1240x1240px · wide-field fundus photograph of an infant:
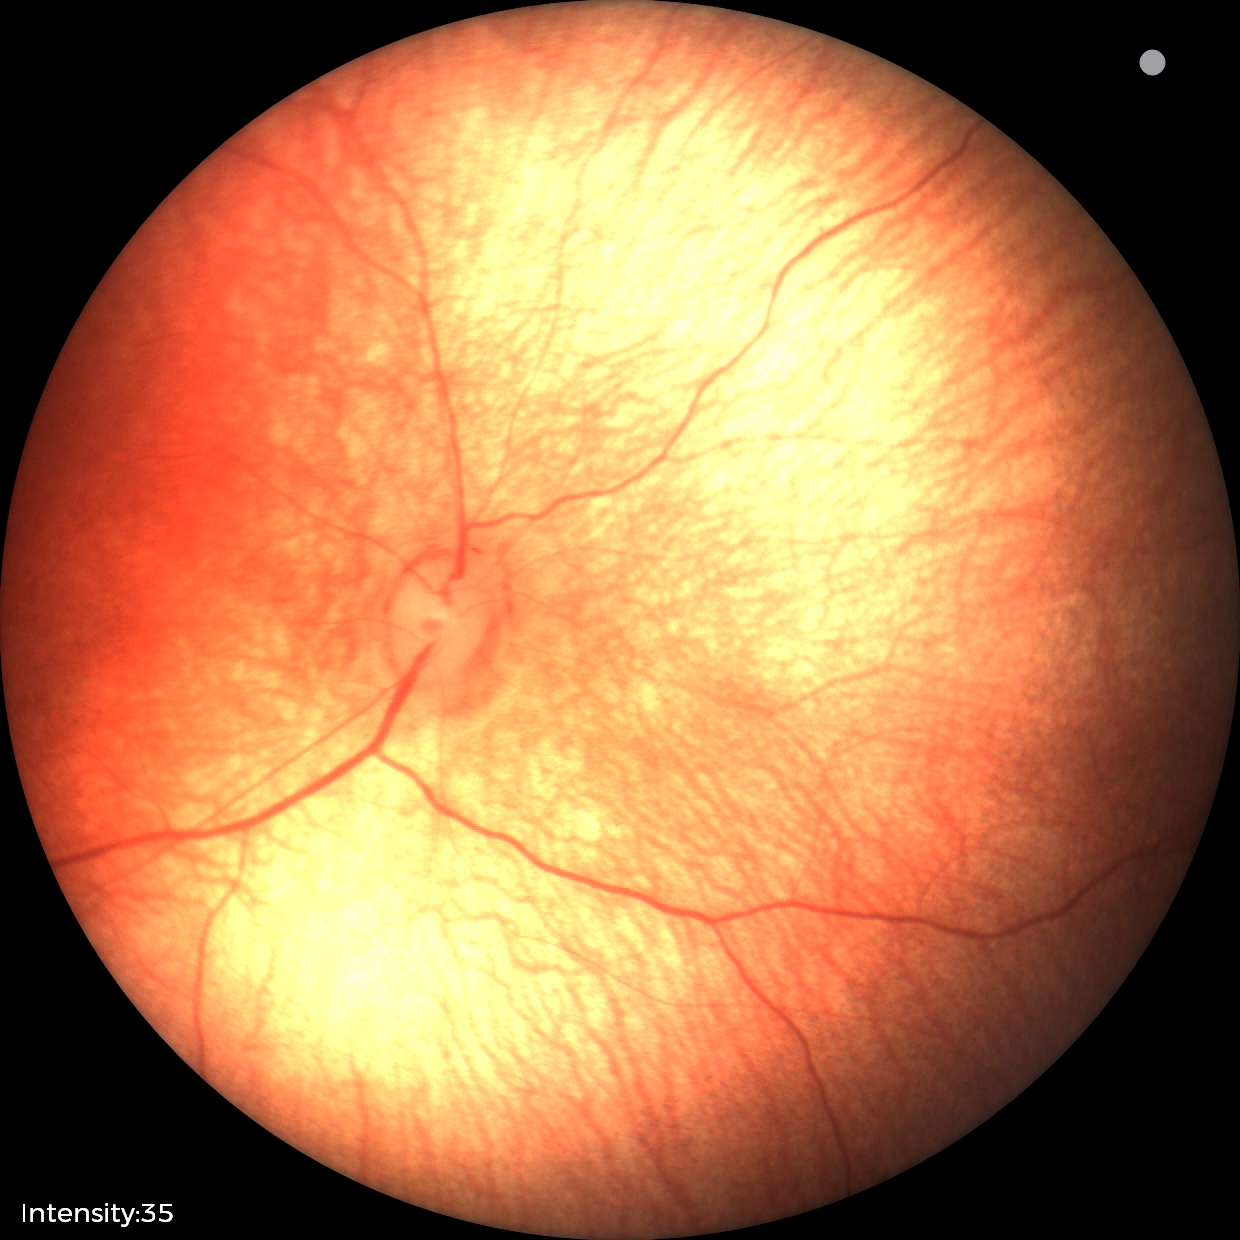 Screening: normal fundus examination.